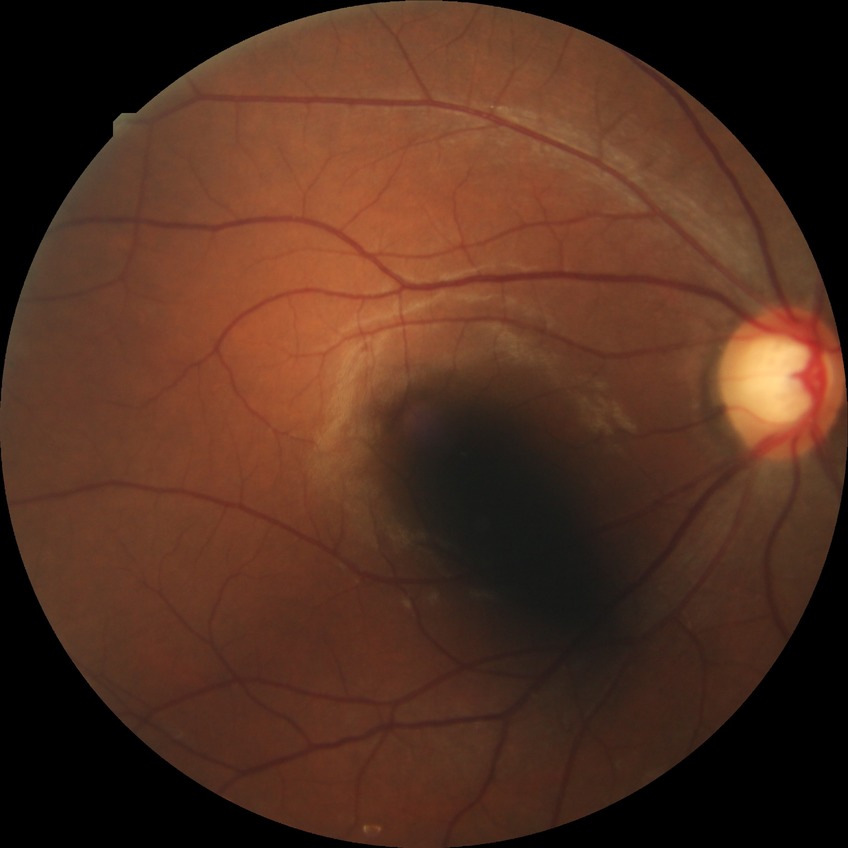

{"davis_grade": "no diabetic retinopathy"}